Infant wide-field fundus photograph — 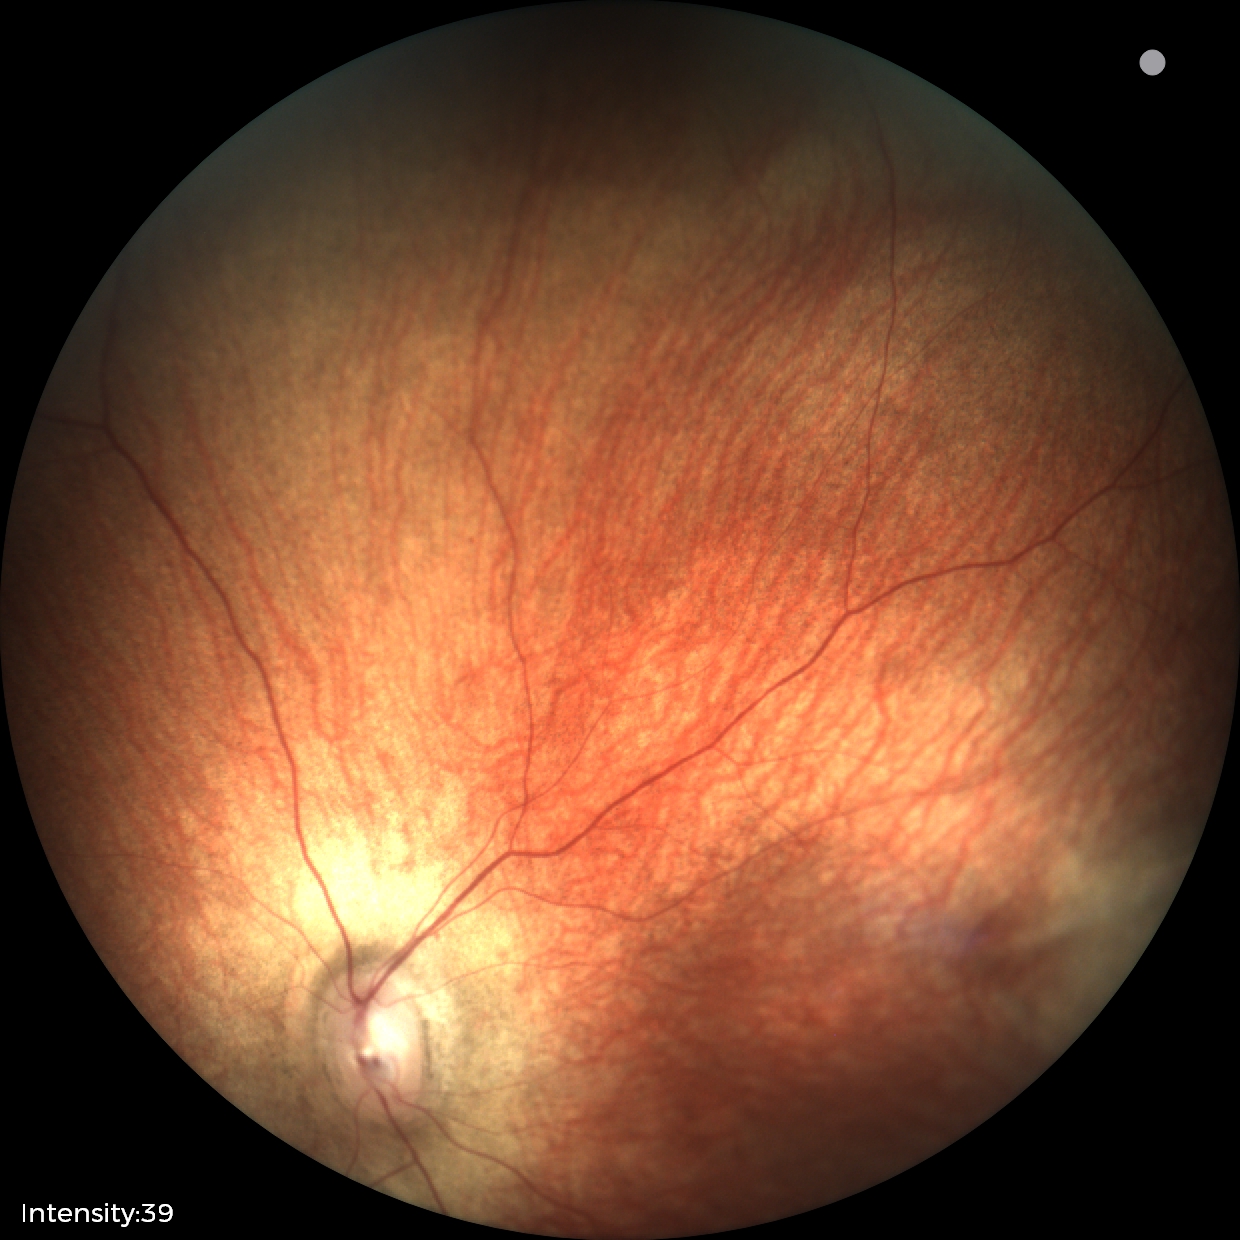

Assessment: physiological retinal finding.